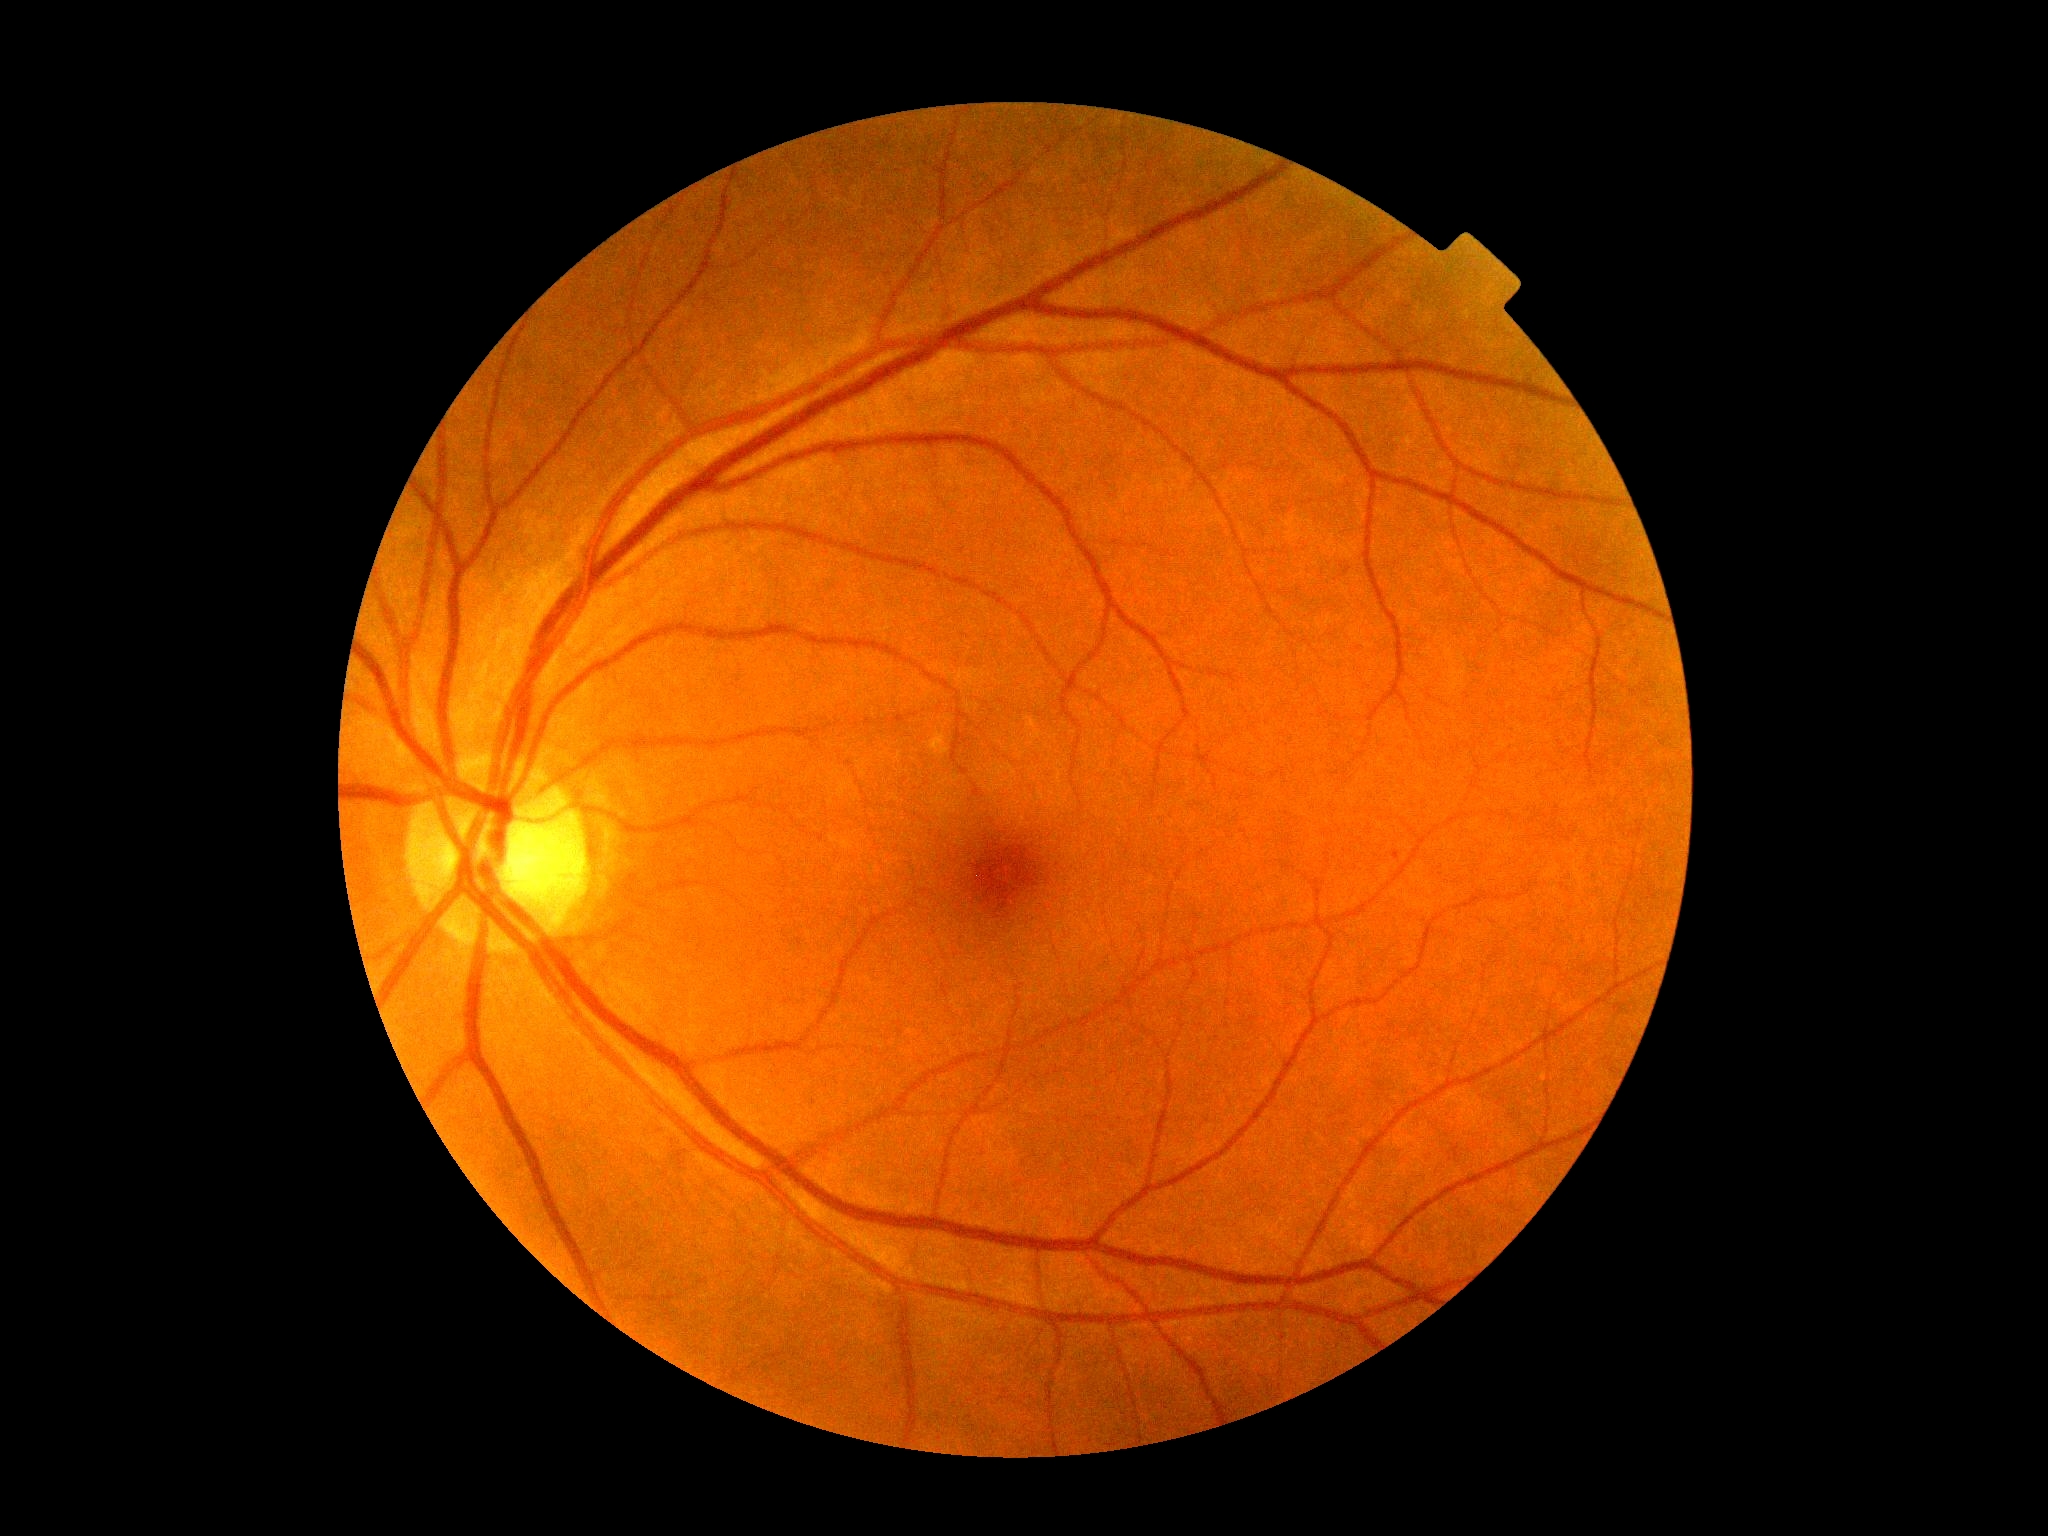 DR: 0/4.